45-degree field of view: 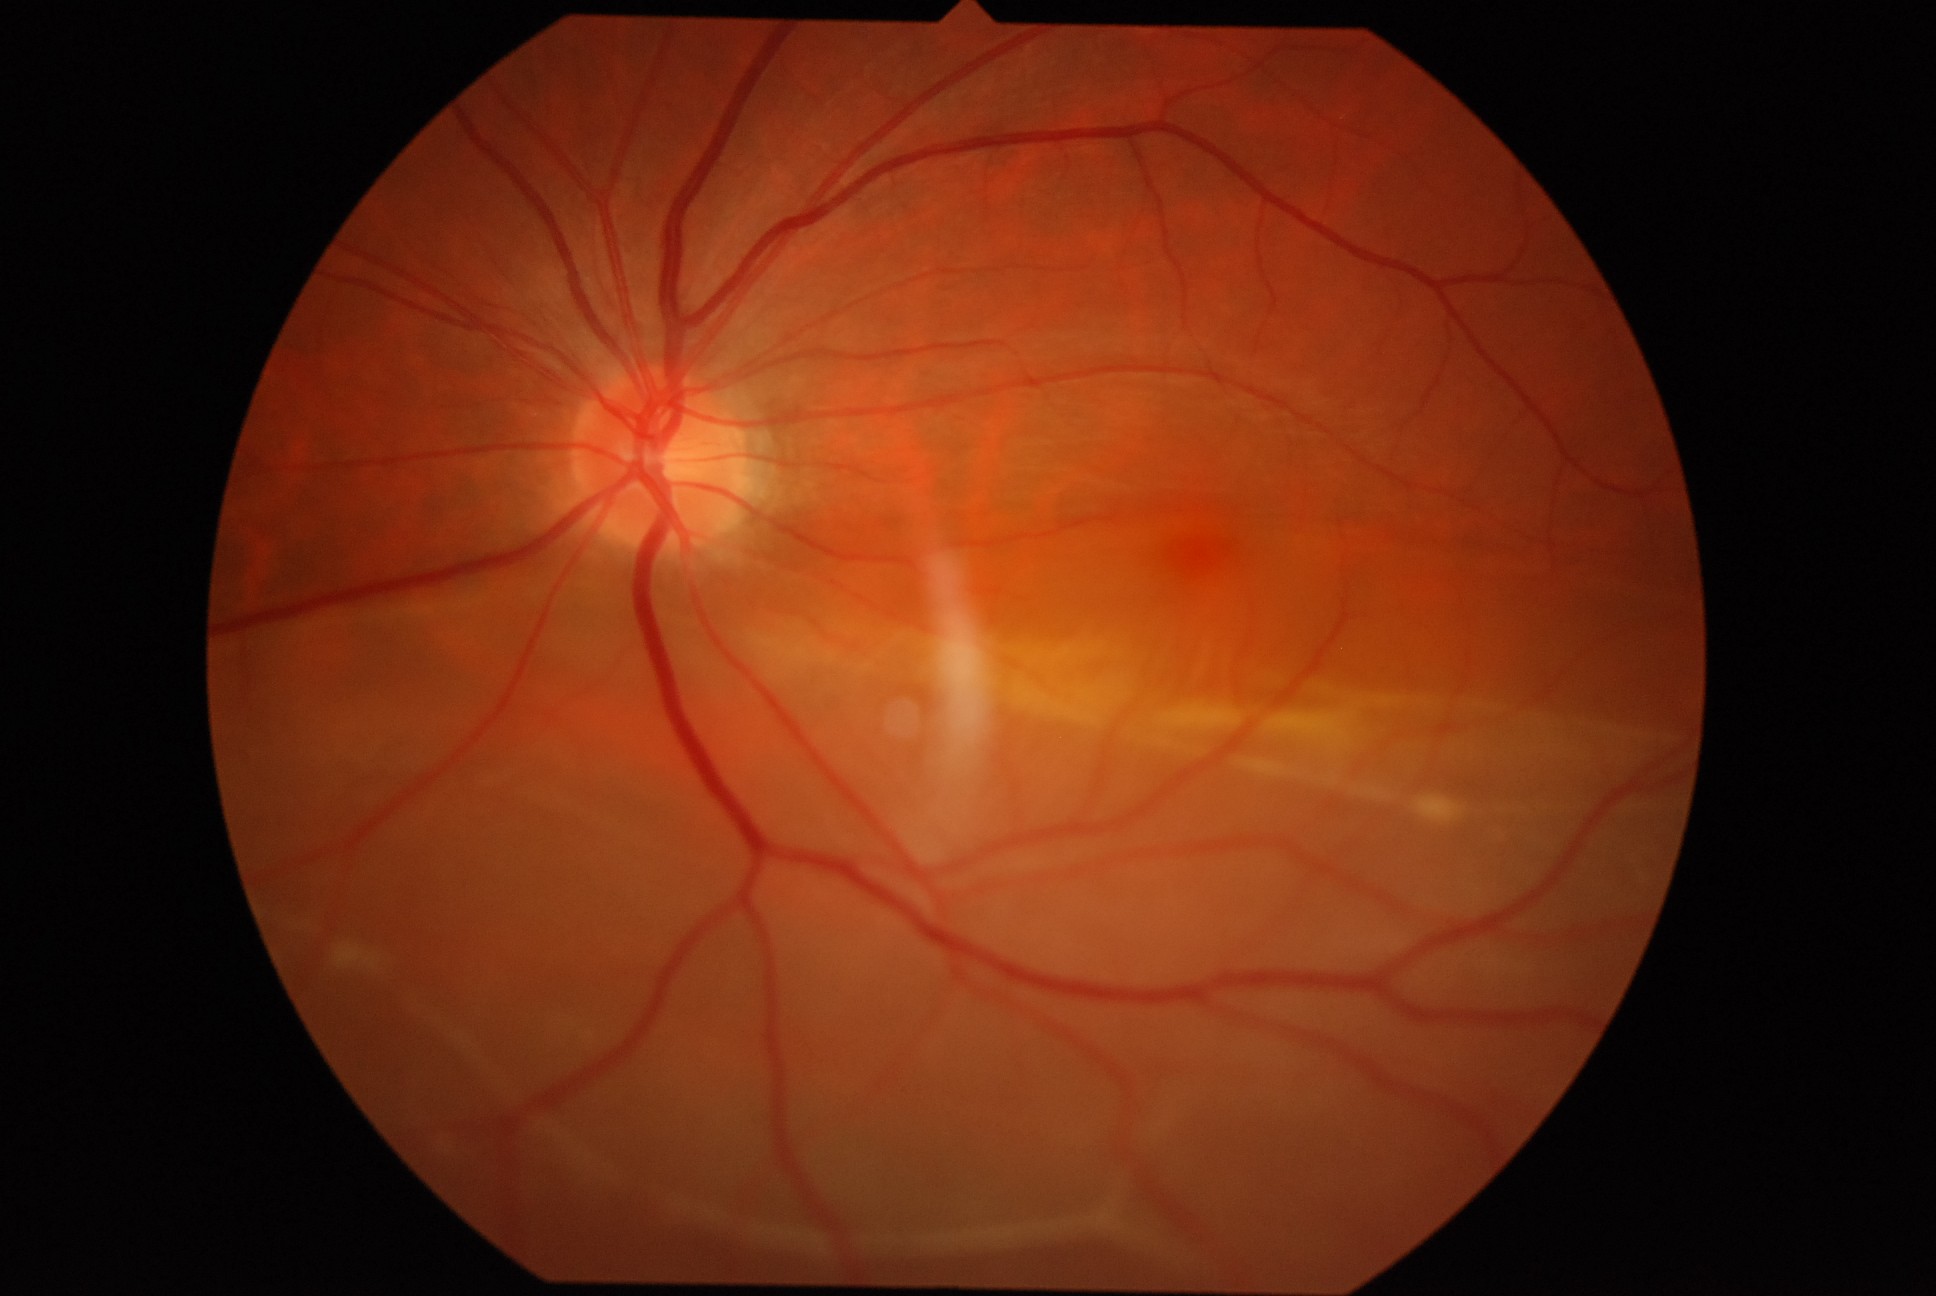 Annotations:
* DR stage — PDR (grade 4)
* DR class — proliferative diabetic retinopathy